FOV: 45 degrees; 2212x1659; fundus photo
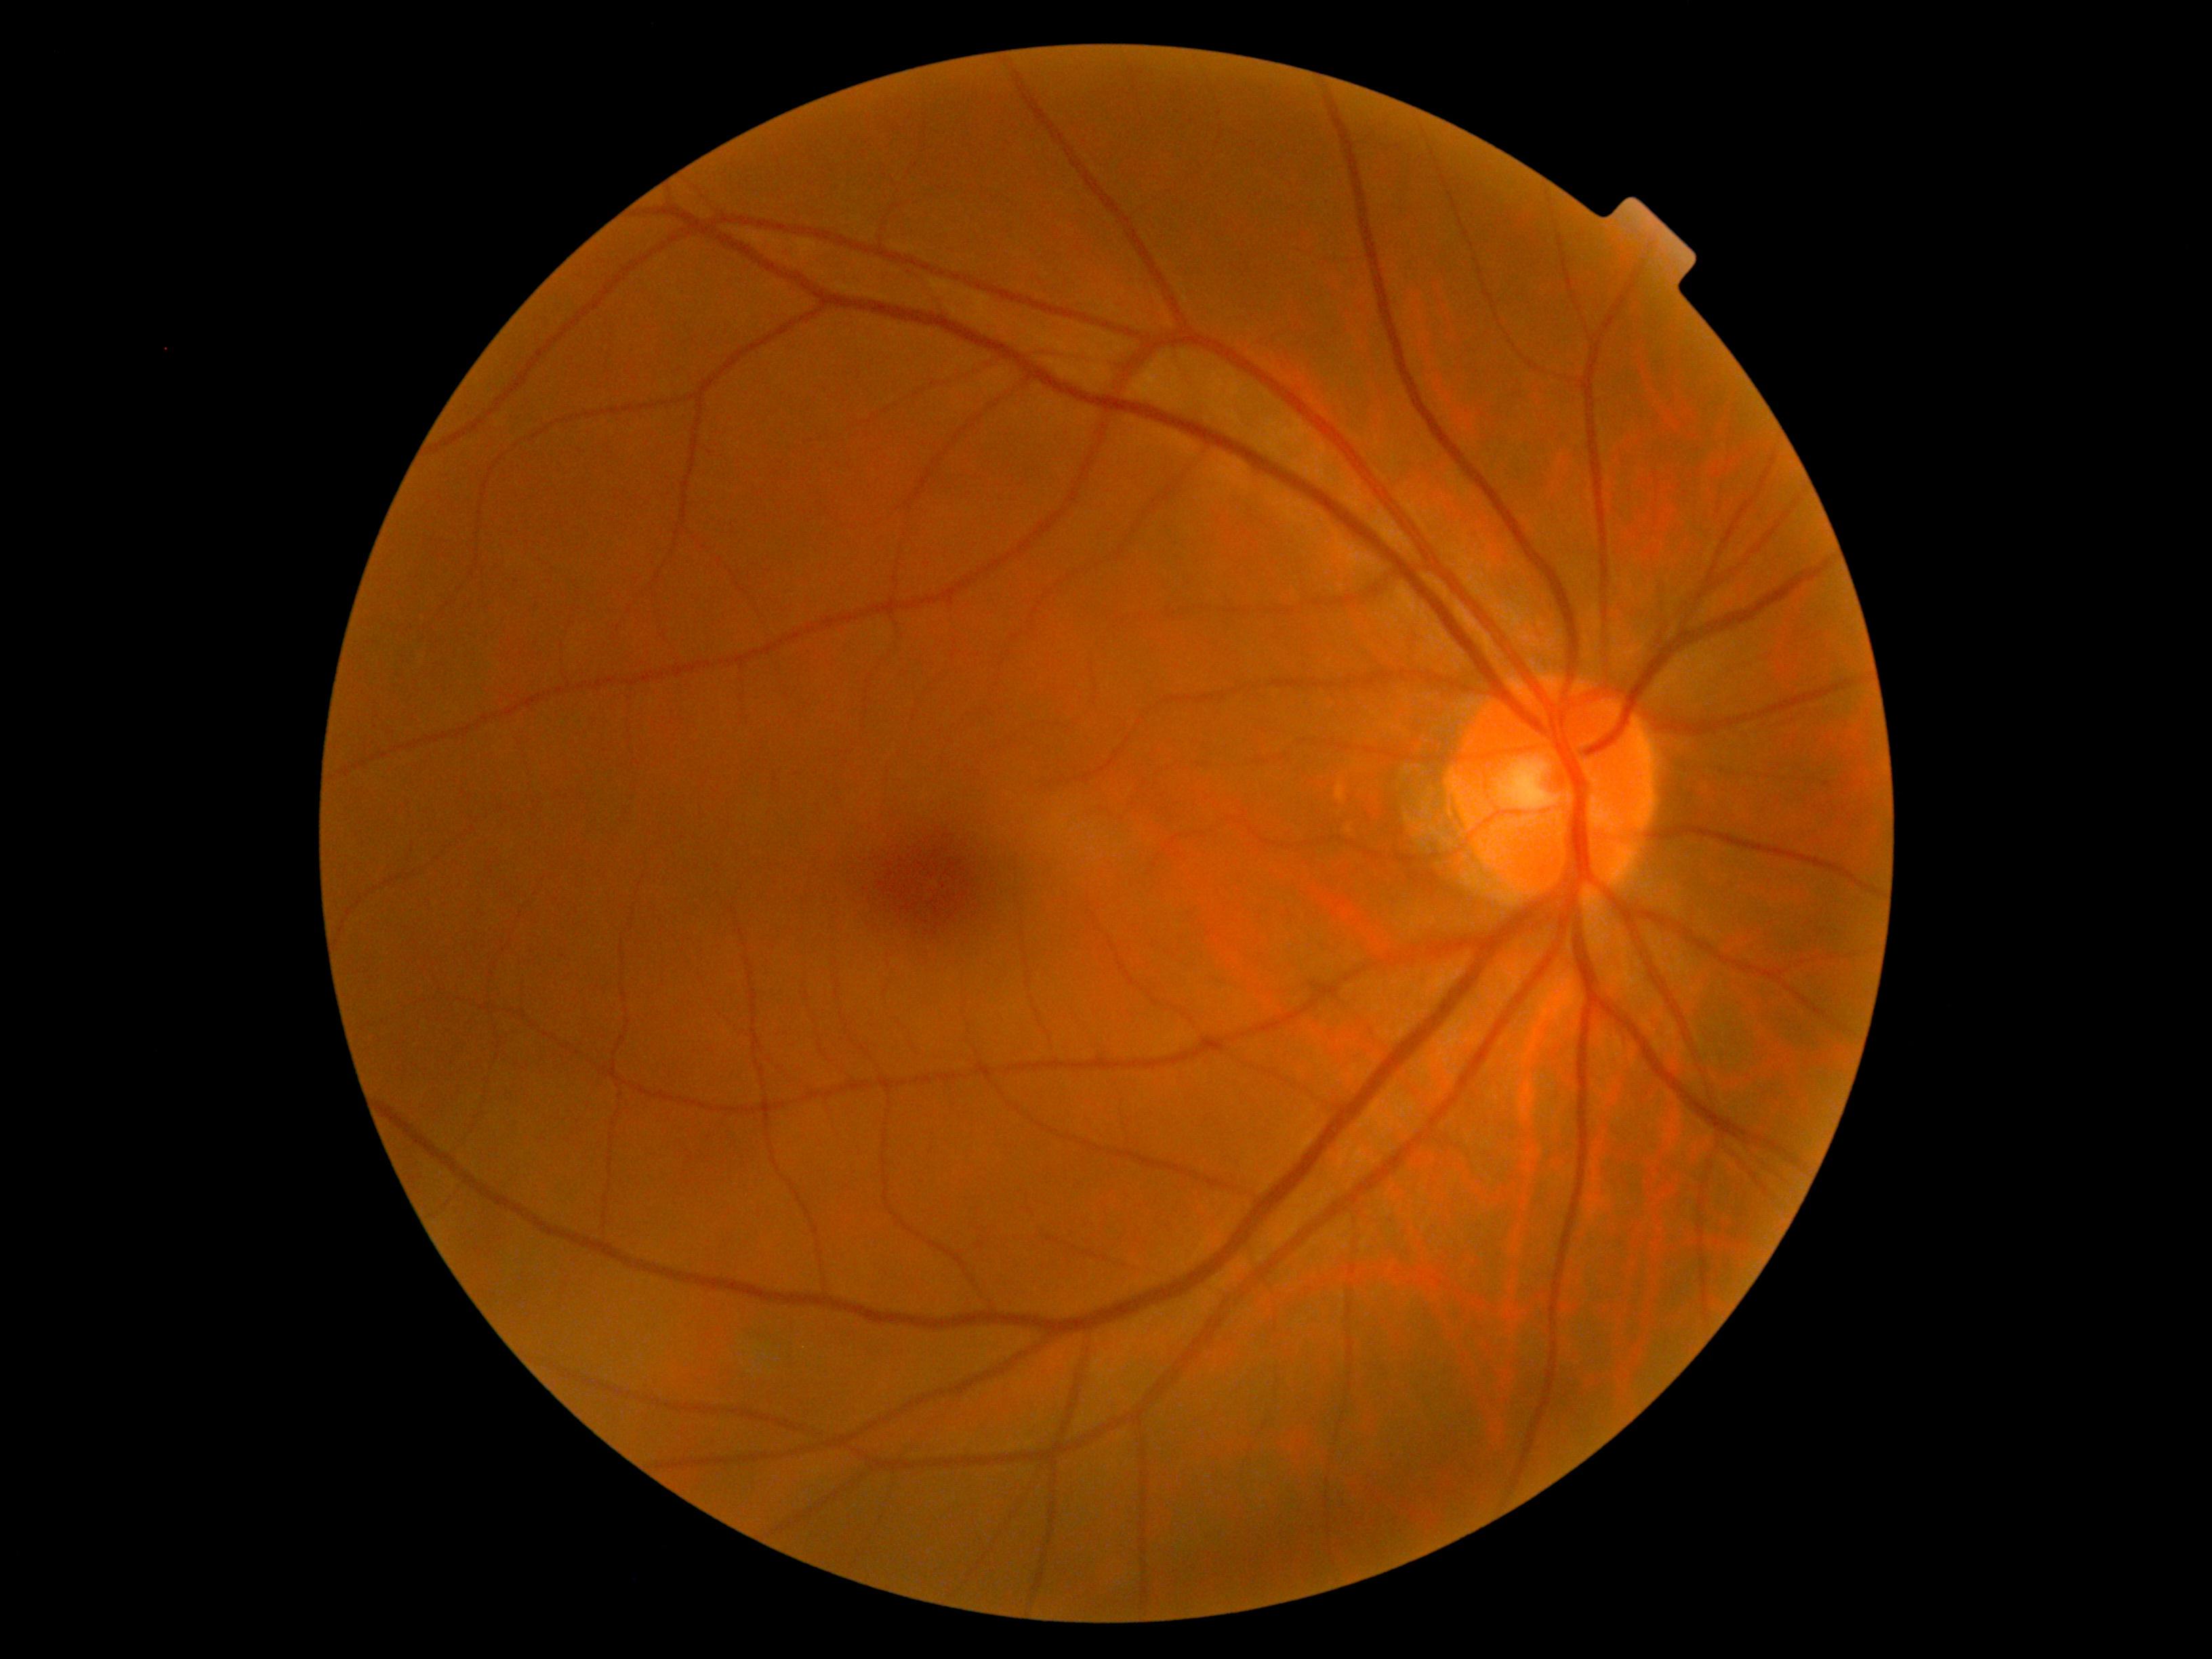
Diabetic retinopathy (DR) is 0.